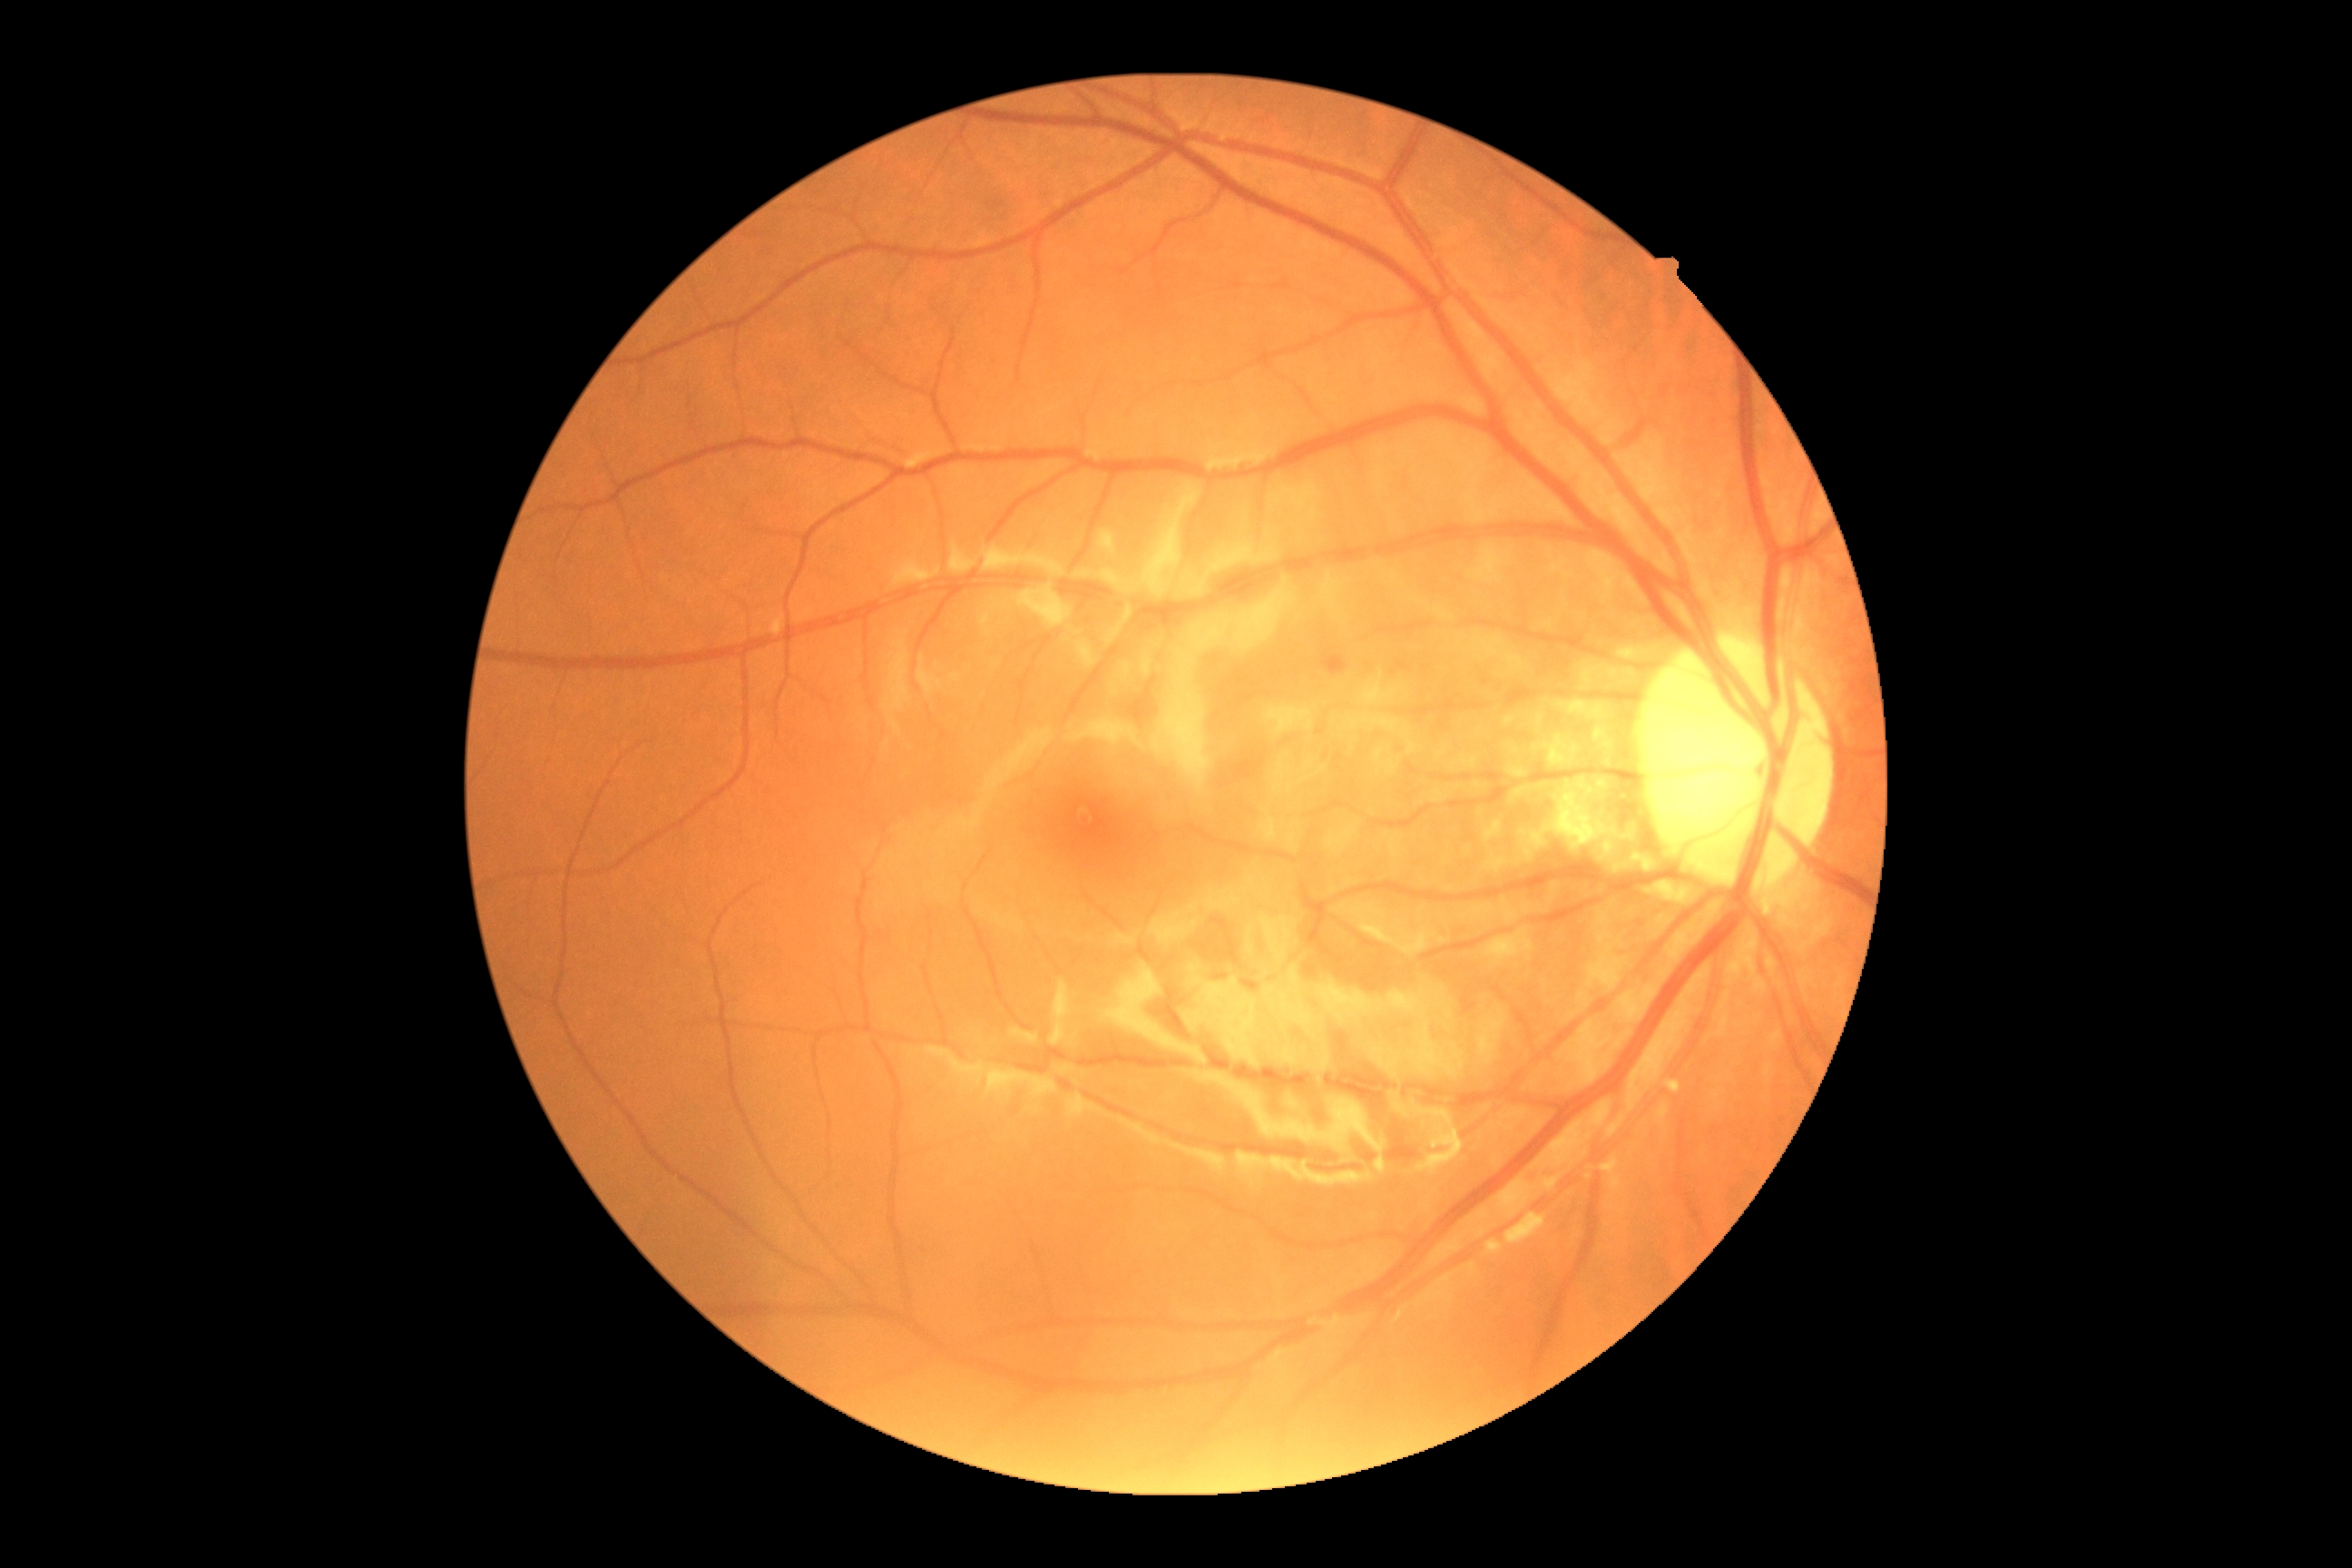 DR is grade 2.